Color fundus image — 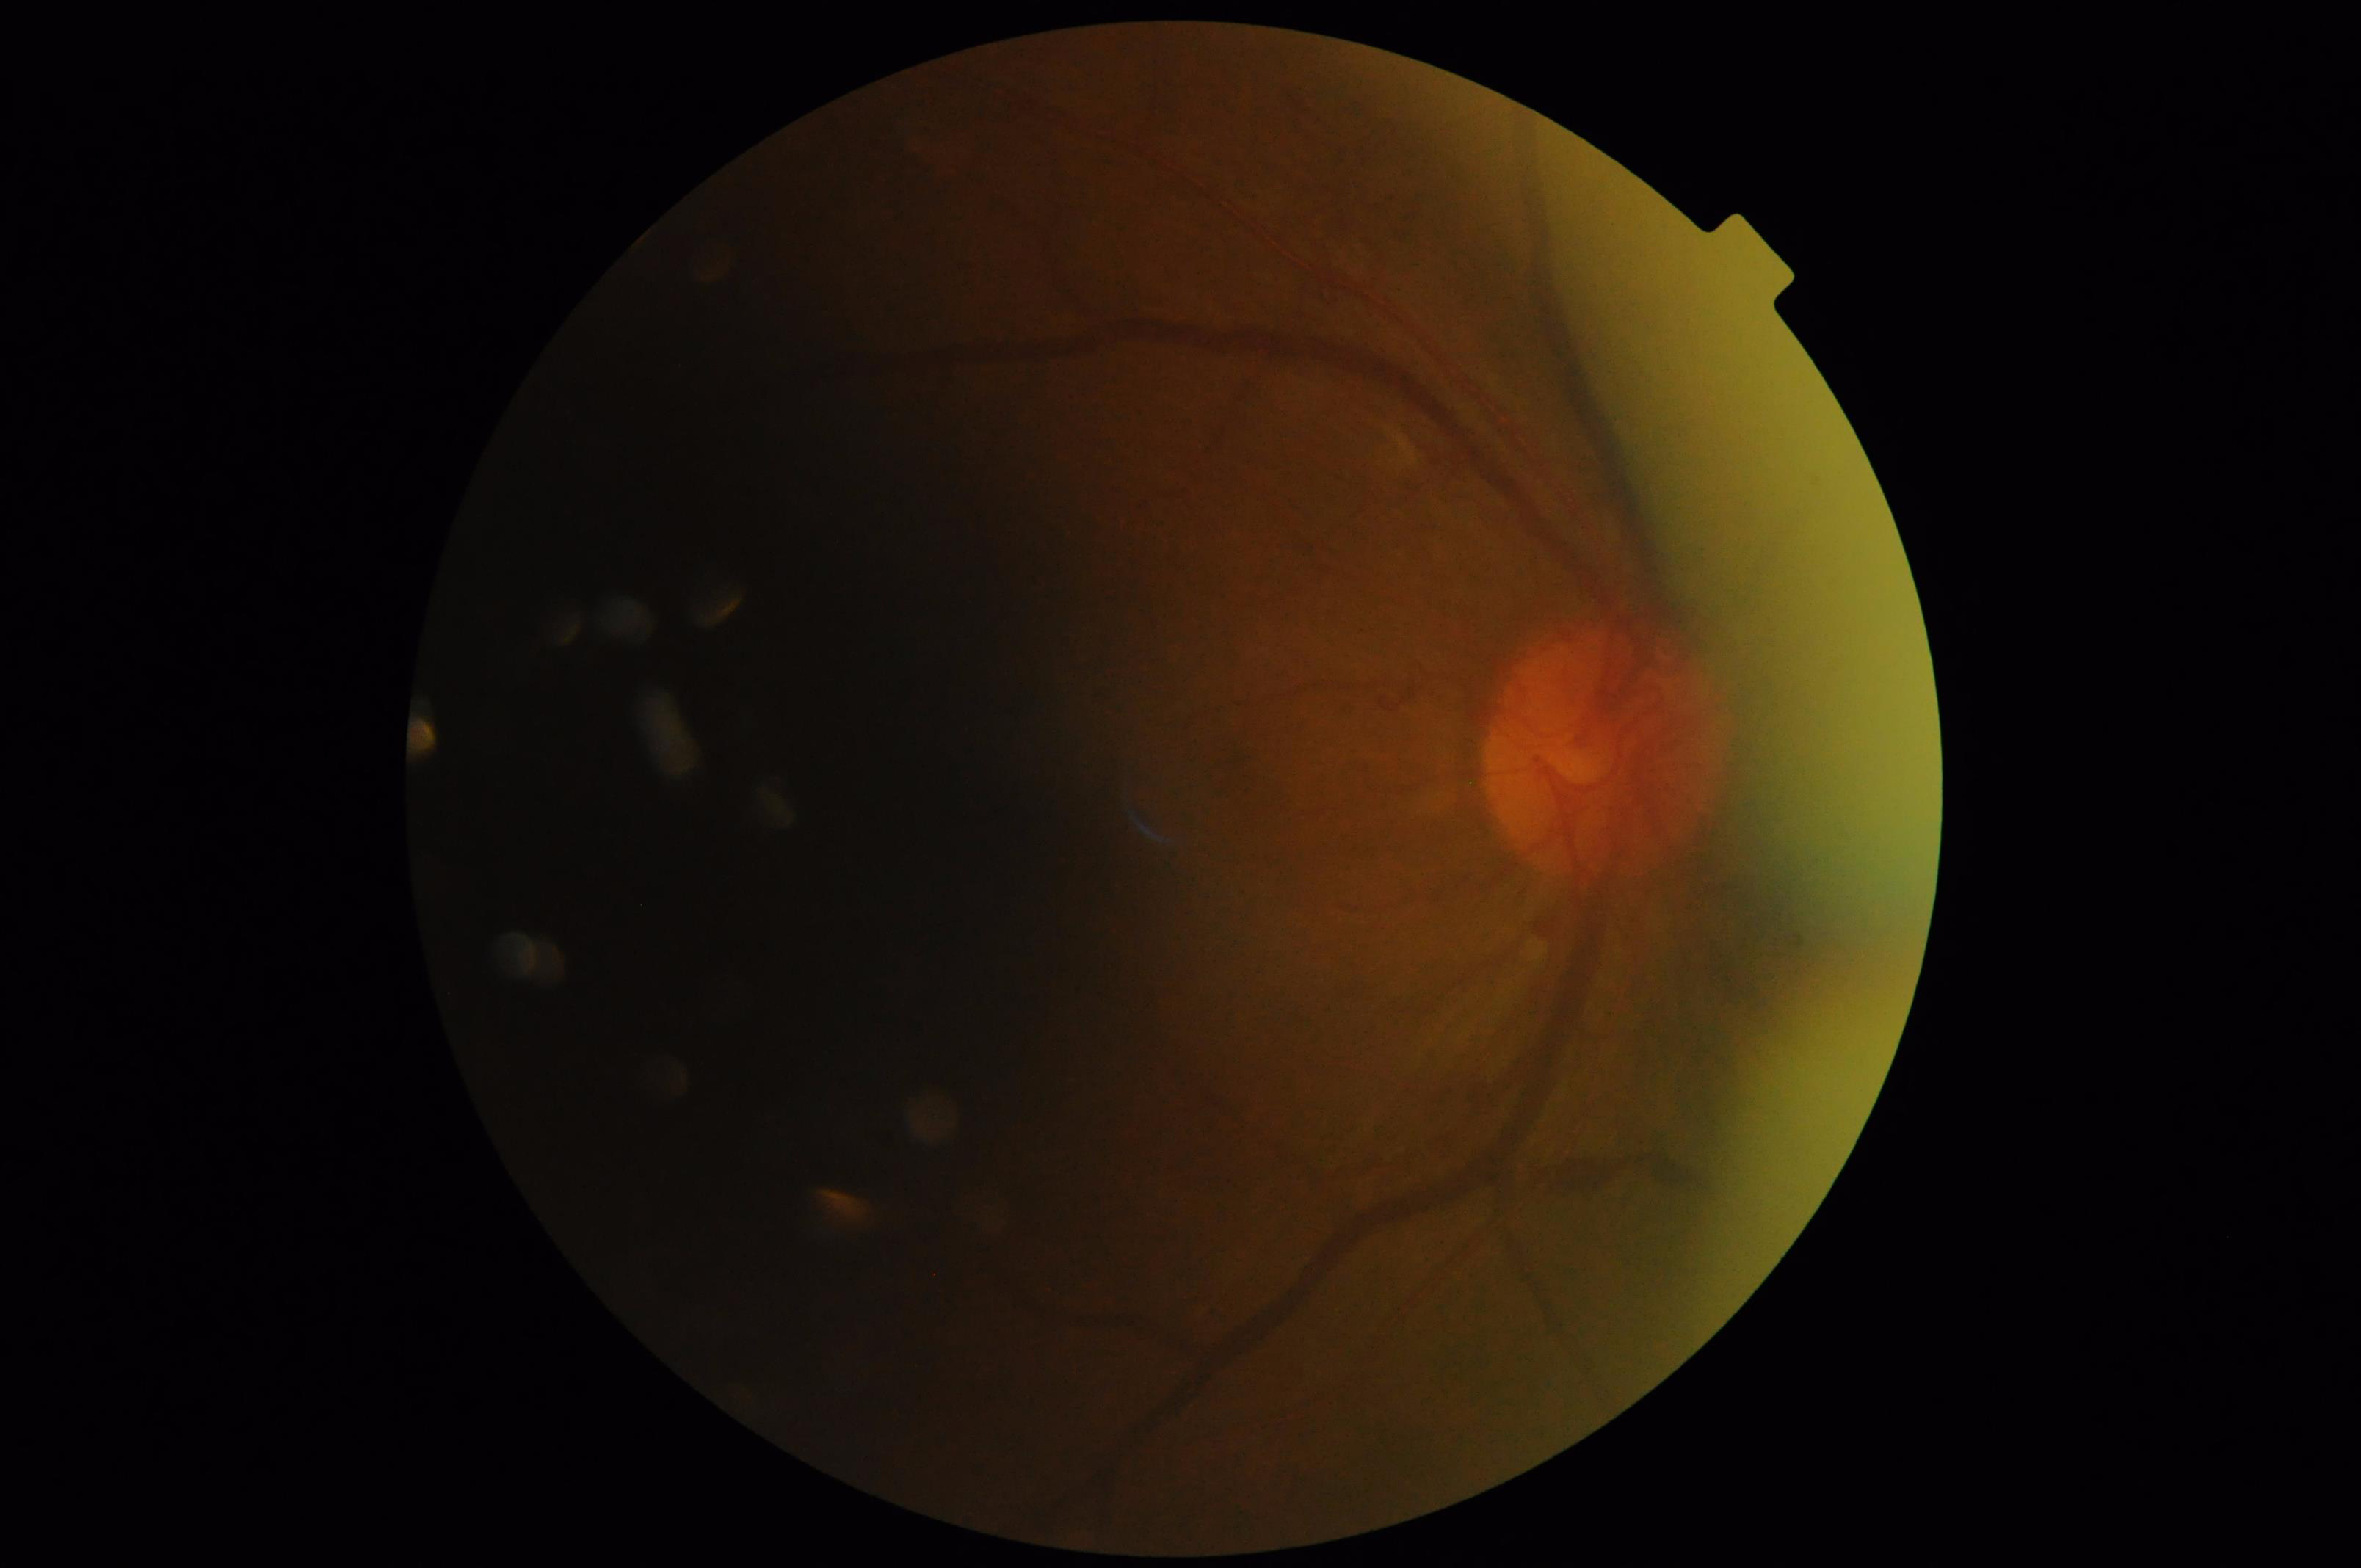 Narrow intensity range; structures are hard to distinguish. Illumination is uneven. Optic disc, vessels, and background are in focus. Overall quality is poor; the image is difficult to grade.